1240 by 1240 pixels · captured with the Phoenix ICON (100° field of view) · wide-field contact fundus photograph of an infant:
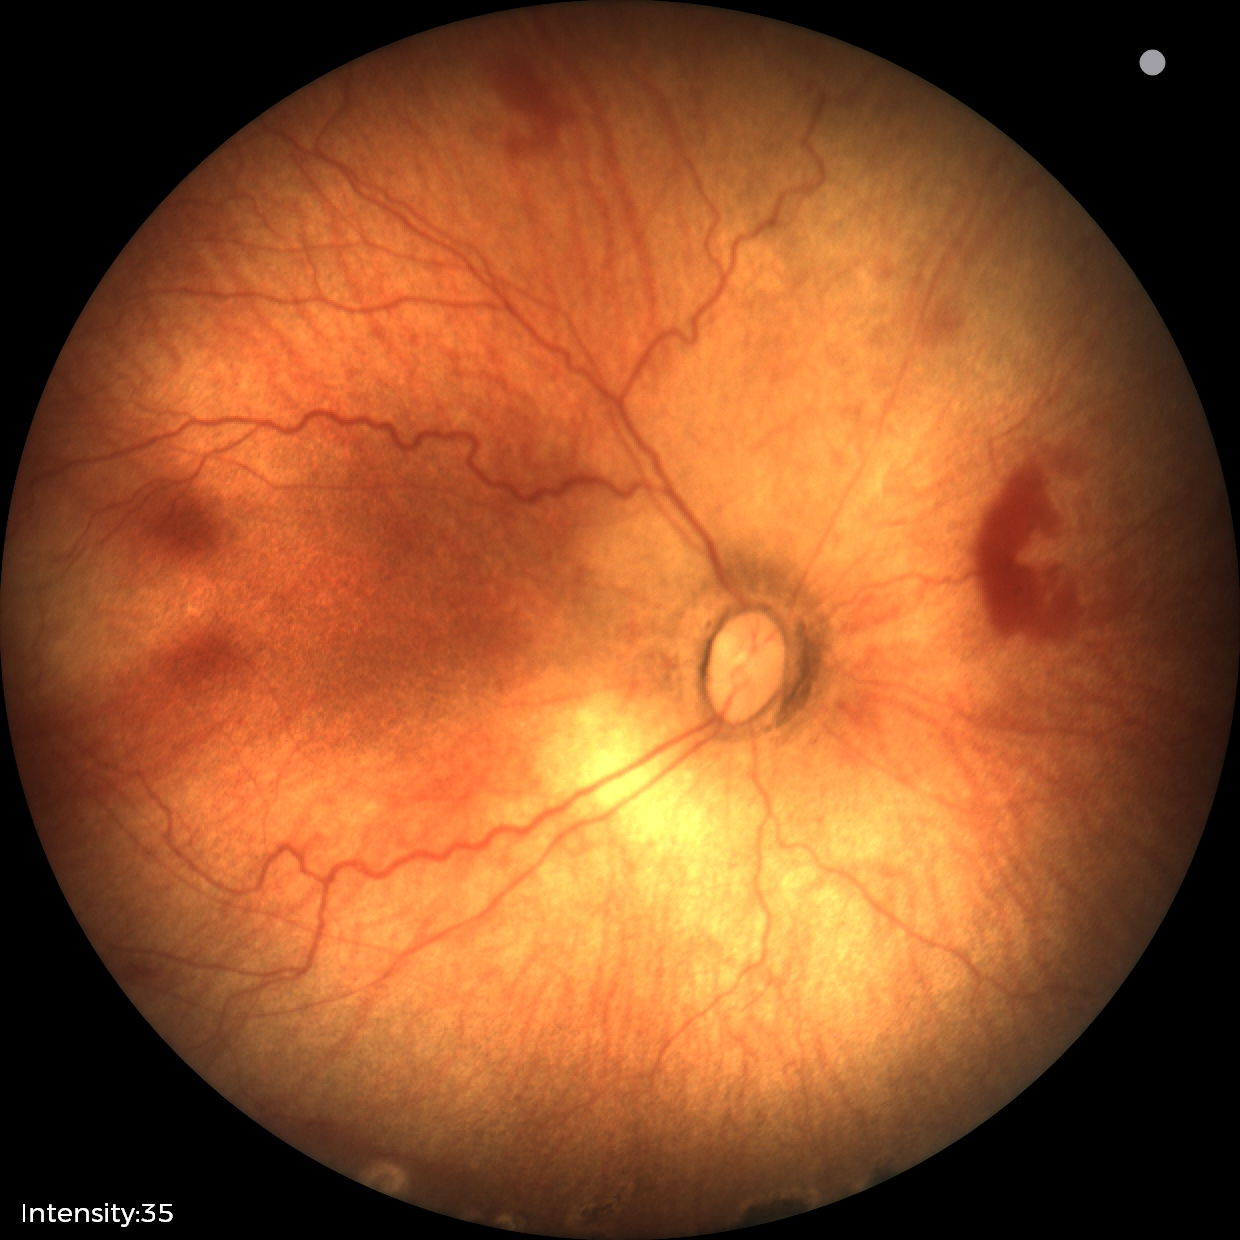

Series diagnosed as status post retinopathy of prematurity.